848 x 848 pixels; 45° FOV; modified Davis classification:
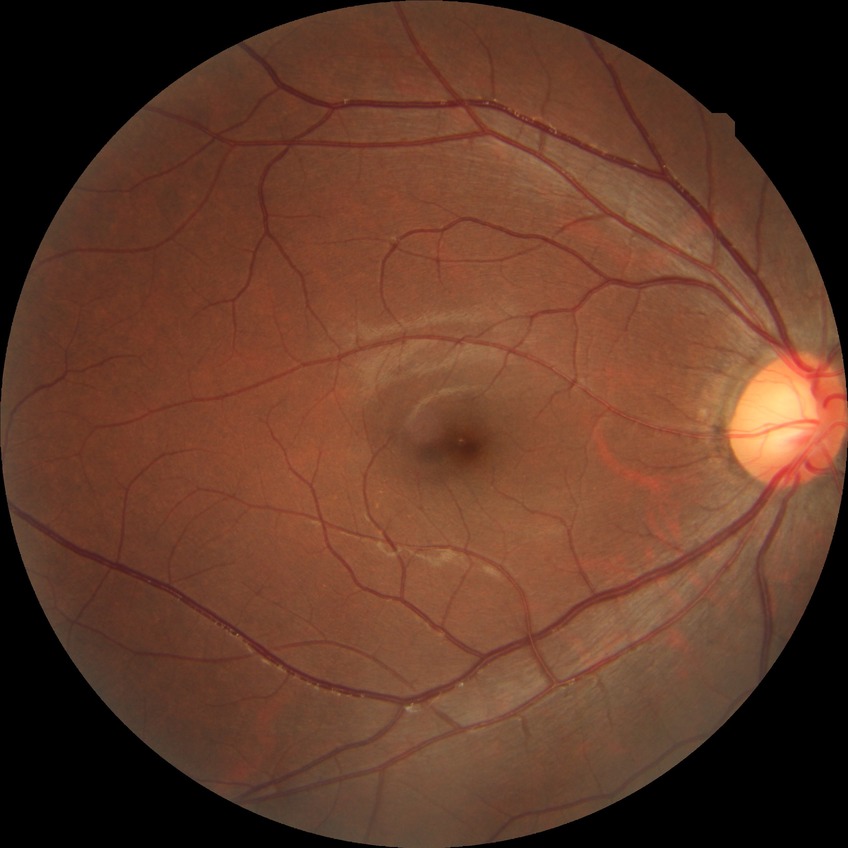
Diabetic retinopathy (DR): NDR (no diabetic retinopathy).